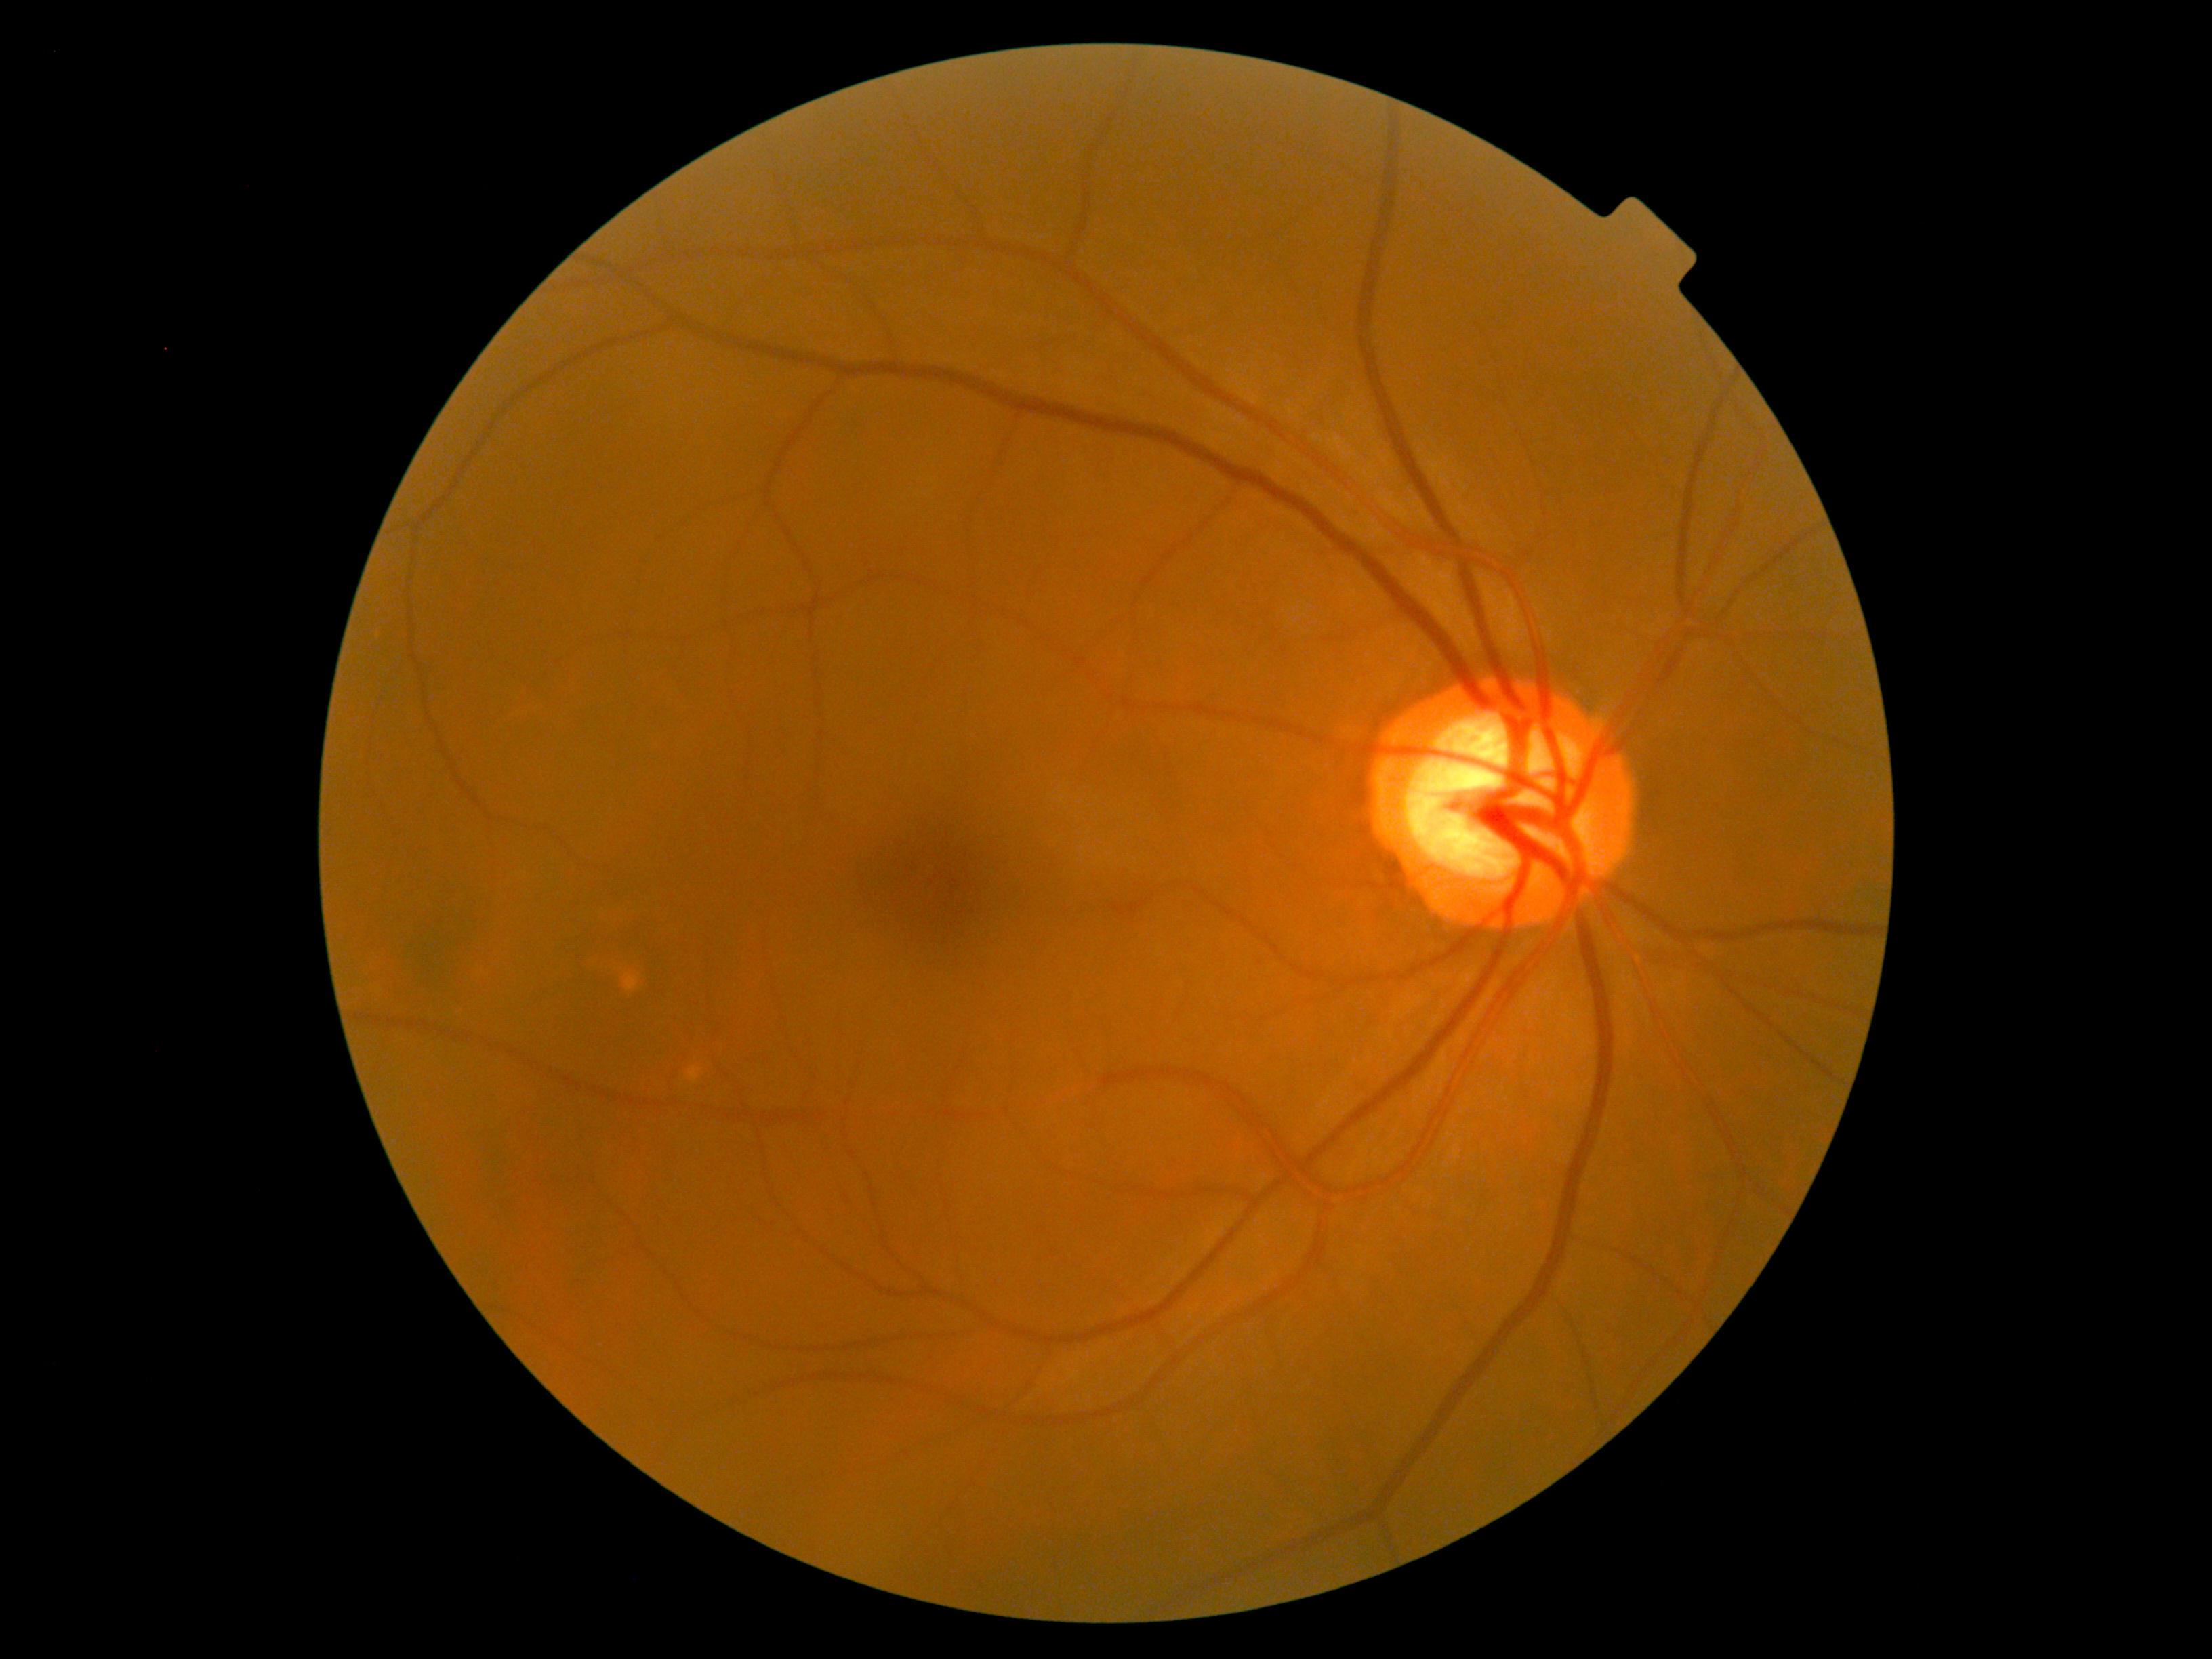
DR stage: grade 0 (no apparent retinopathy), DR impression: no DR findings.